Color fundus photograph. 45° FOV:
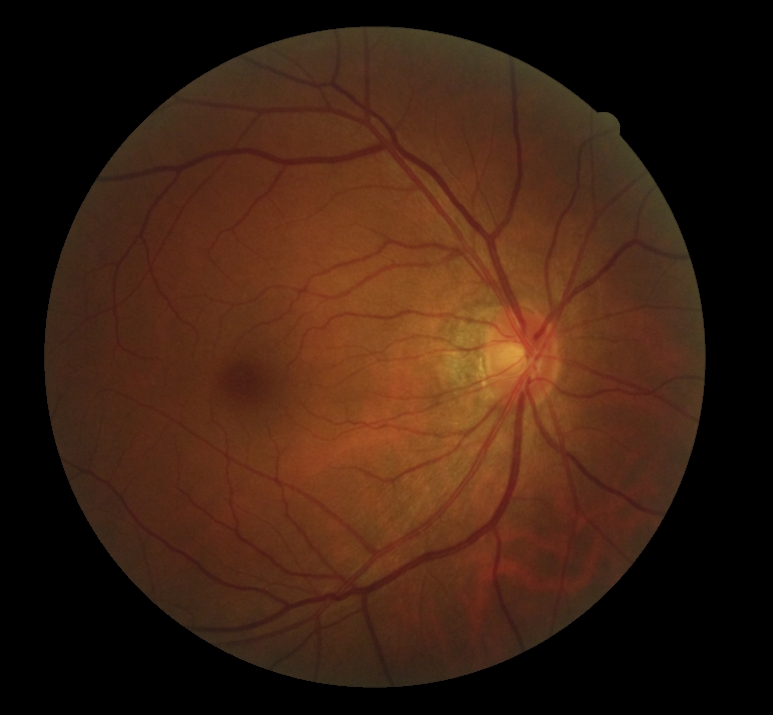
DR = grade 0 (no apparent retinopathy).